DR severity per modified Davis staging. Nonmydriatic fundus photograph:
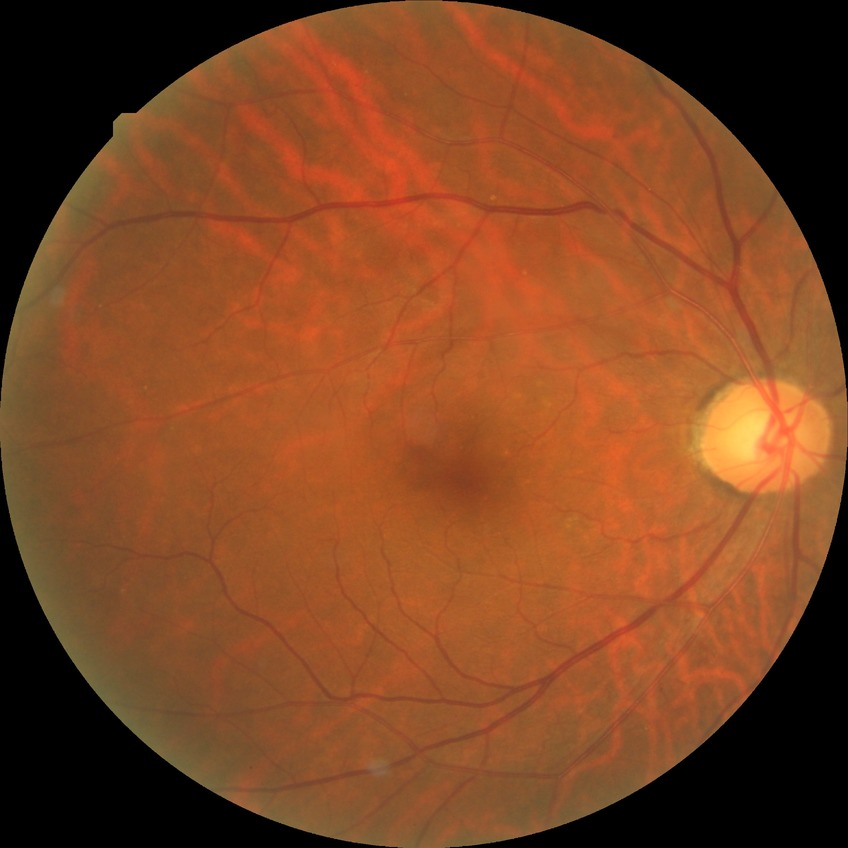

DR: SDR.